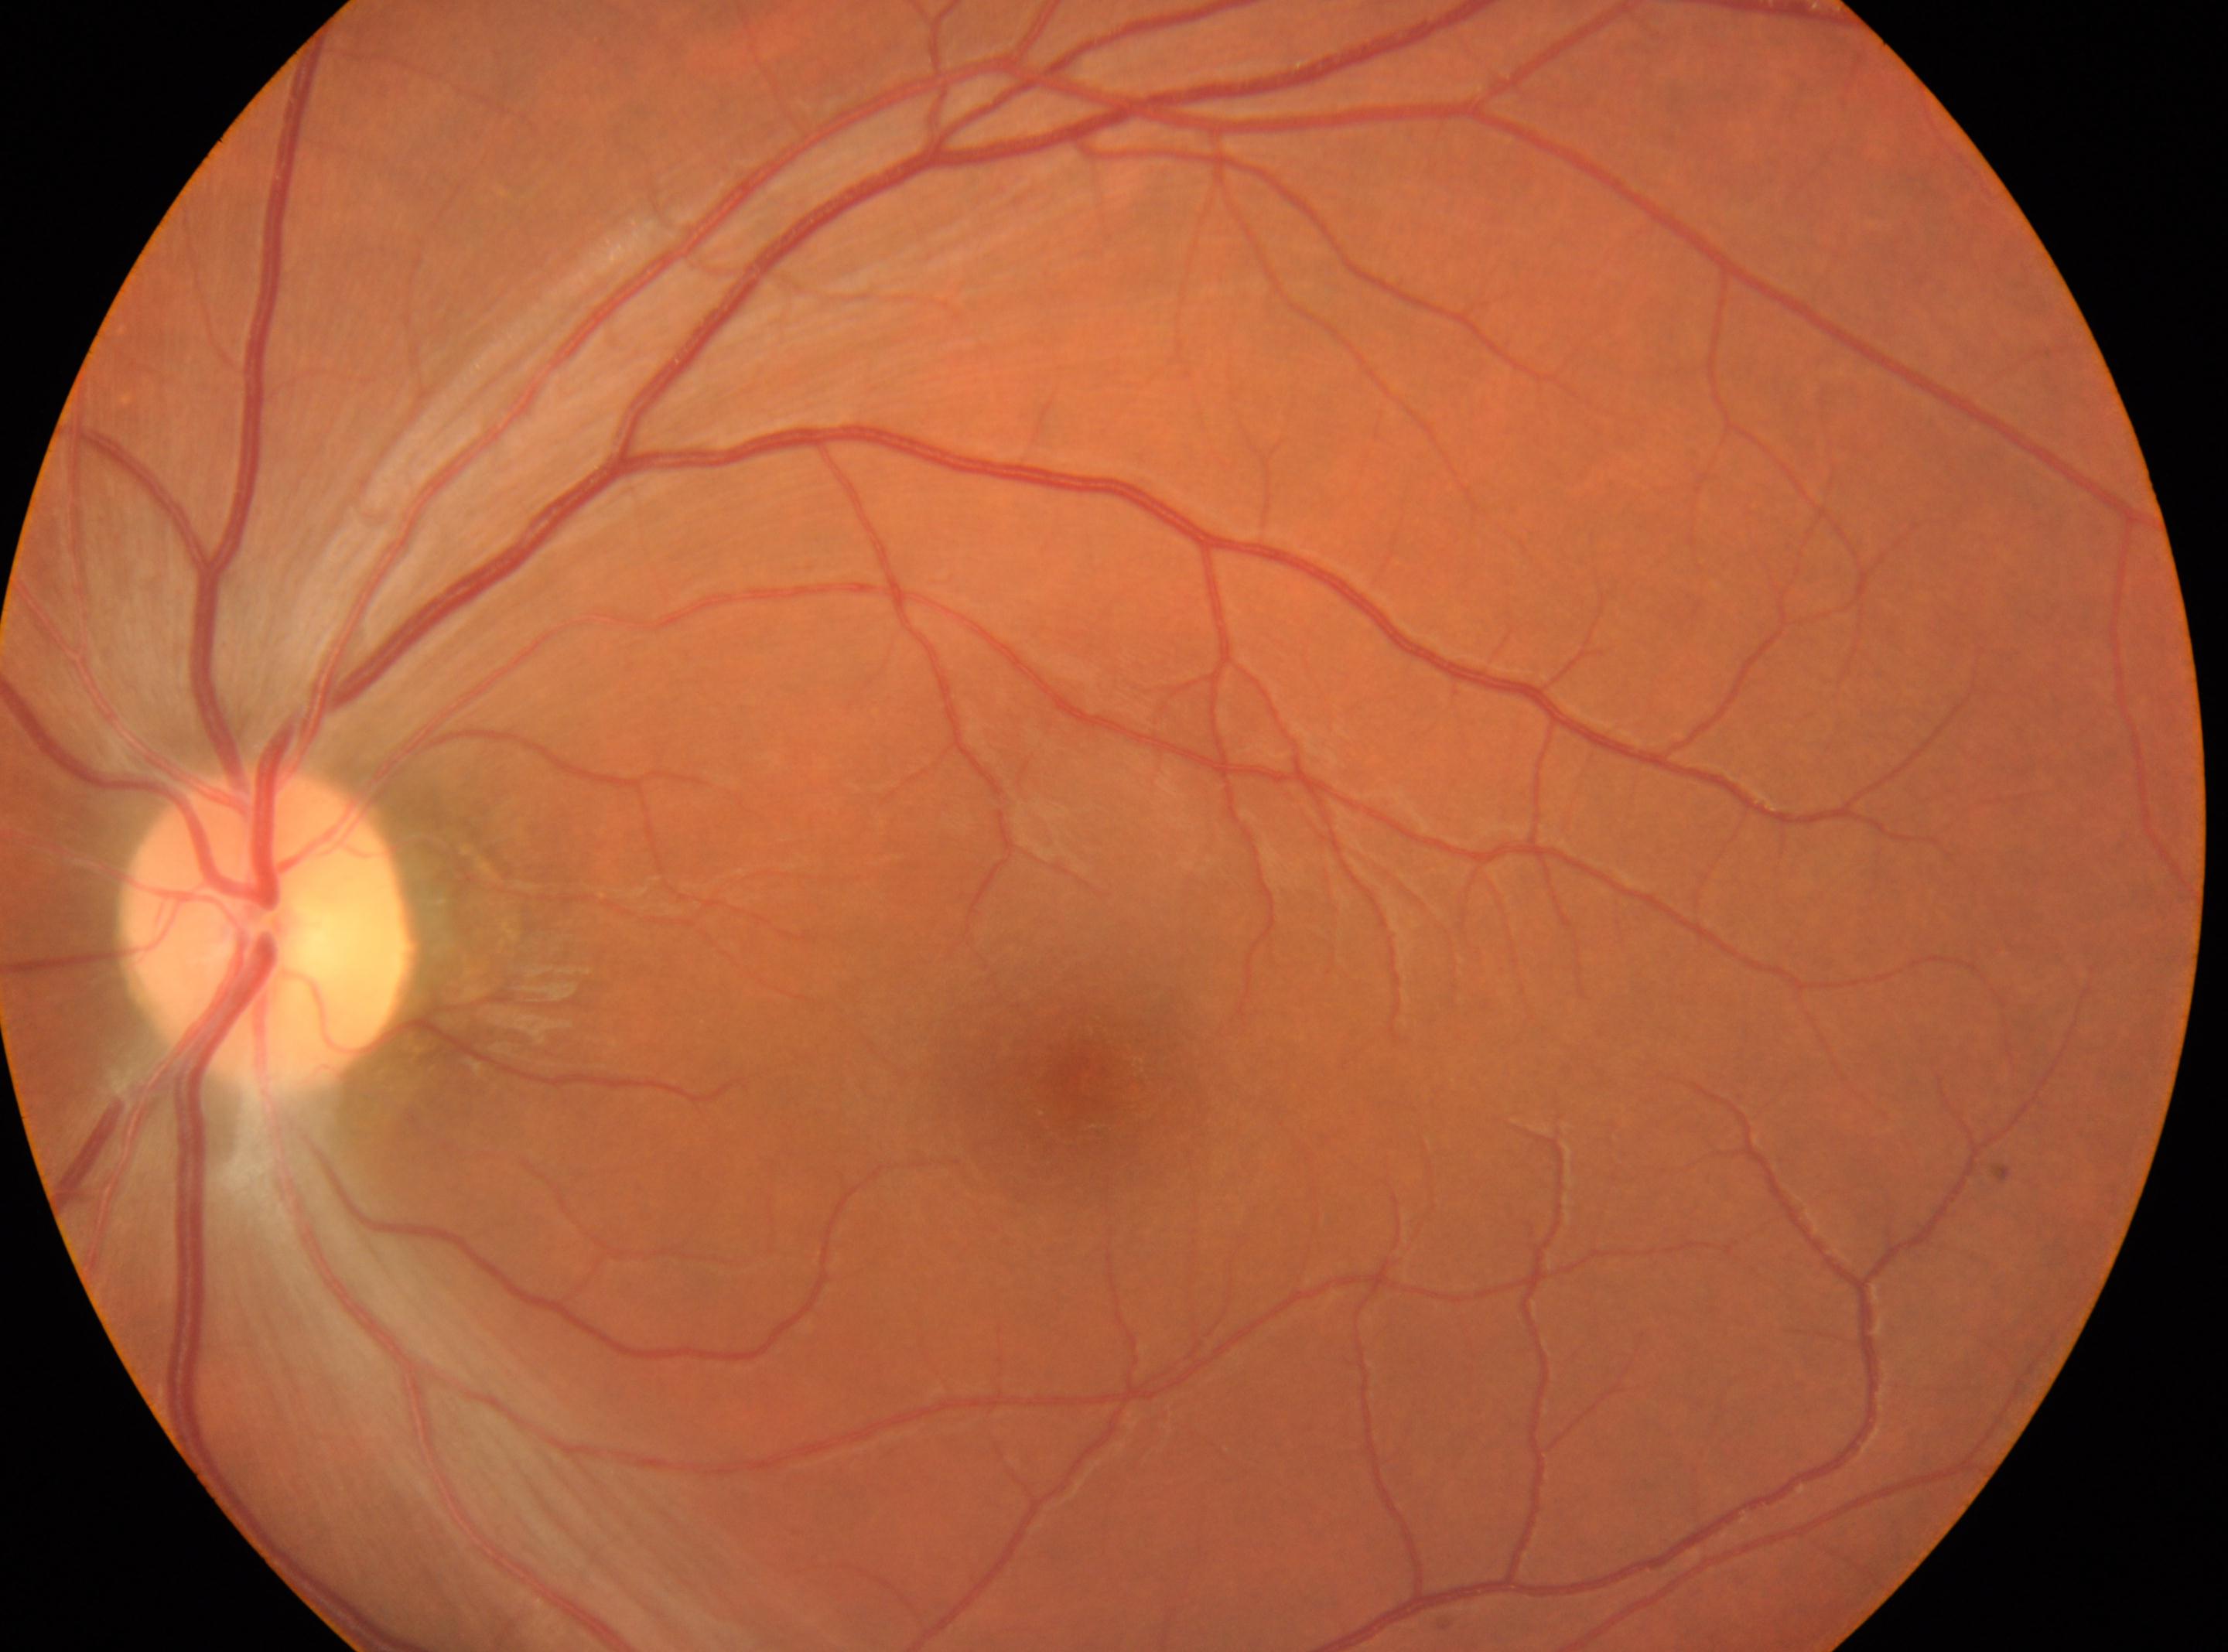

Q: Fovea center?
A: (x=1085, y=1086)
Q: What is the DR grade?
A: 0
Q: What is the laterality?
A: OS
Q: Locate the optic disc.
A: (x=263, y=932)
Q: Any diabetic retinopathy?
A: No apparent diabetic retinopathy